2352x1568px · retinal fundus photograph · 45° field of view
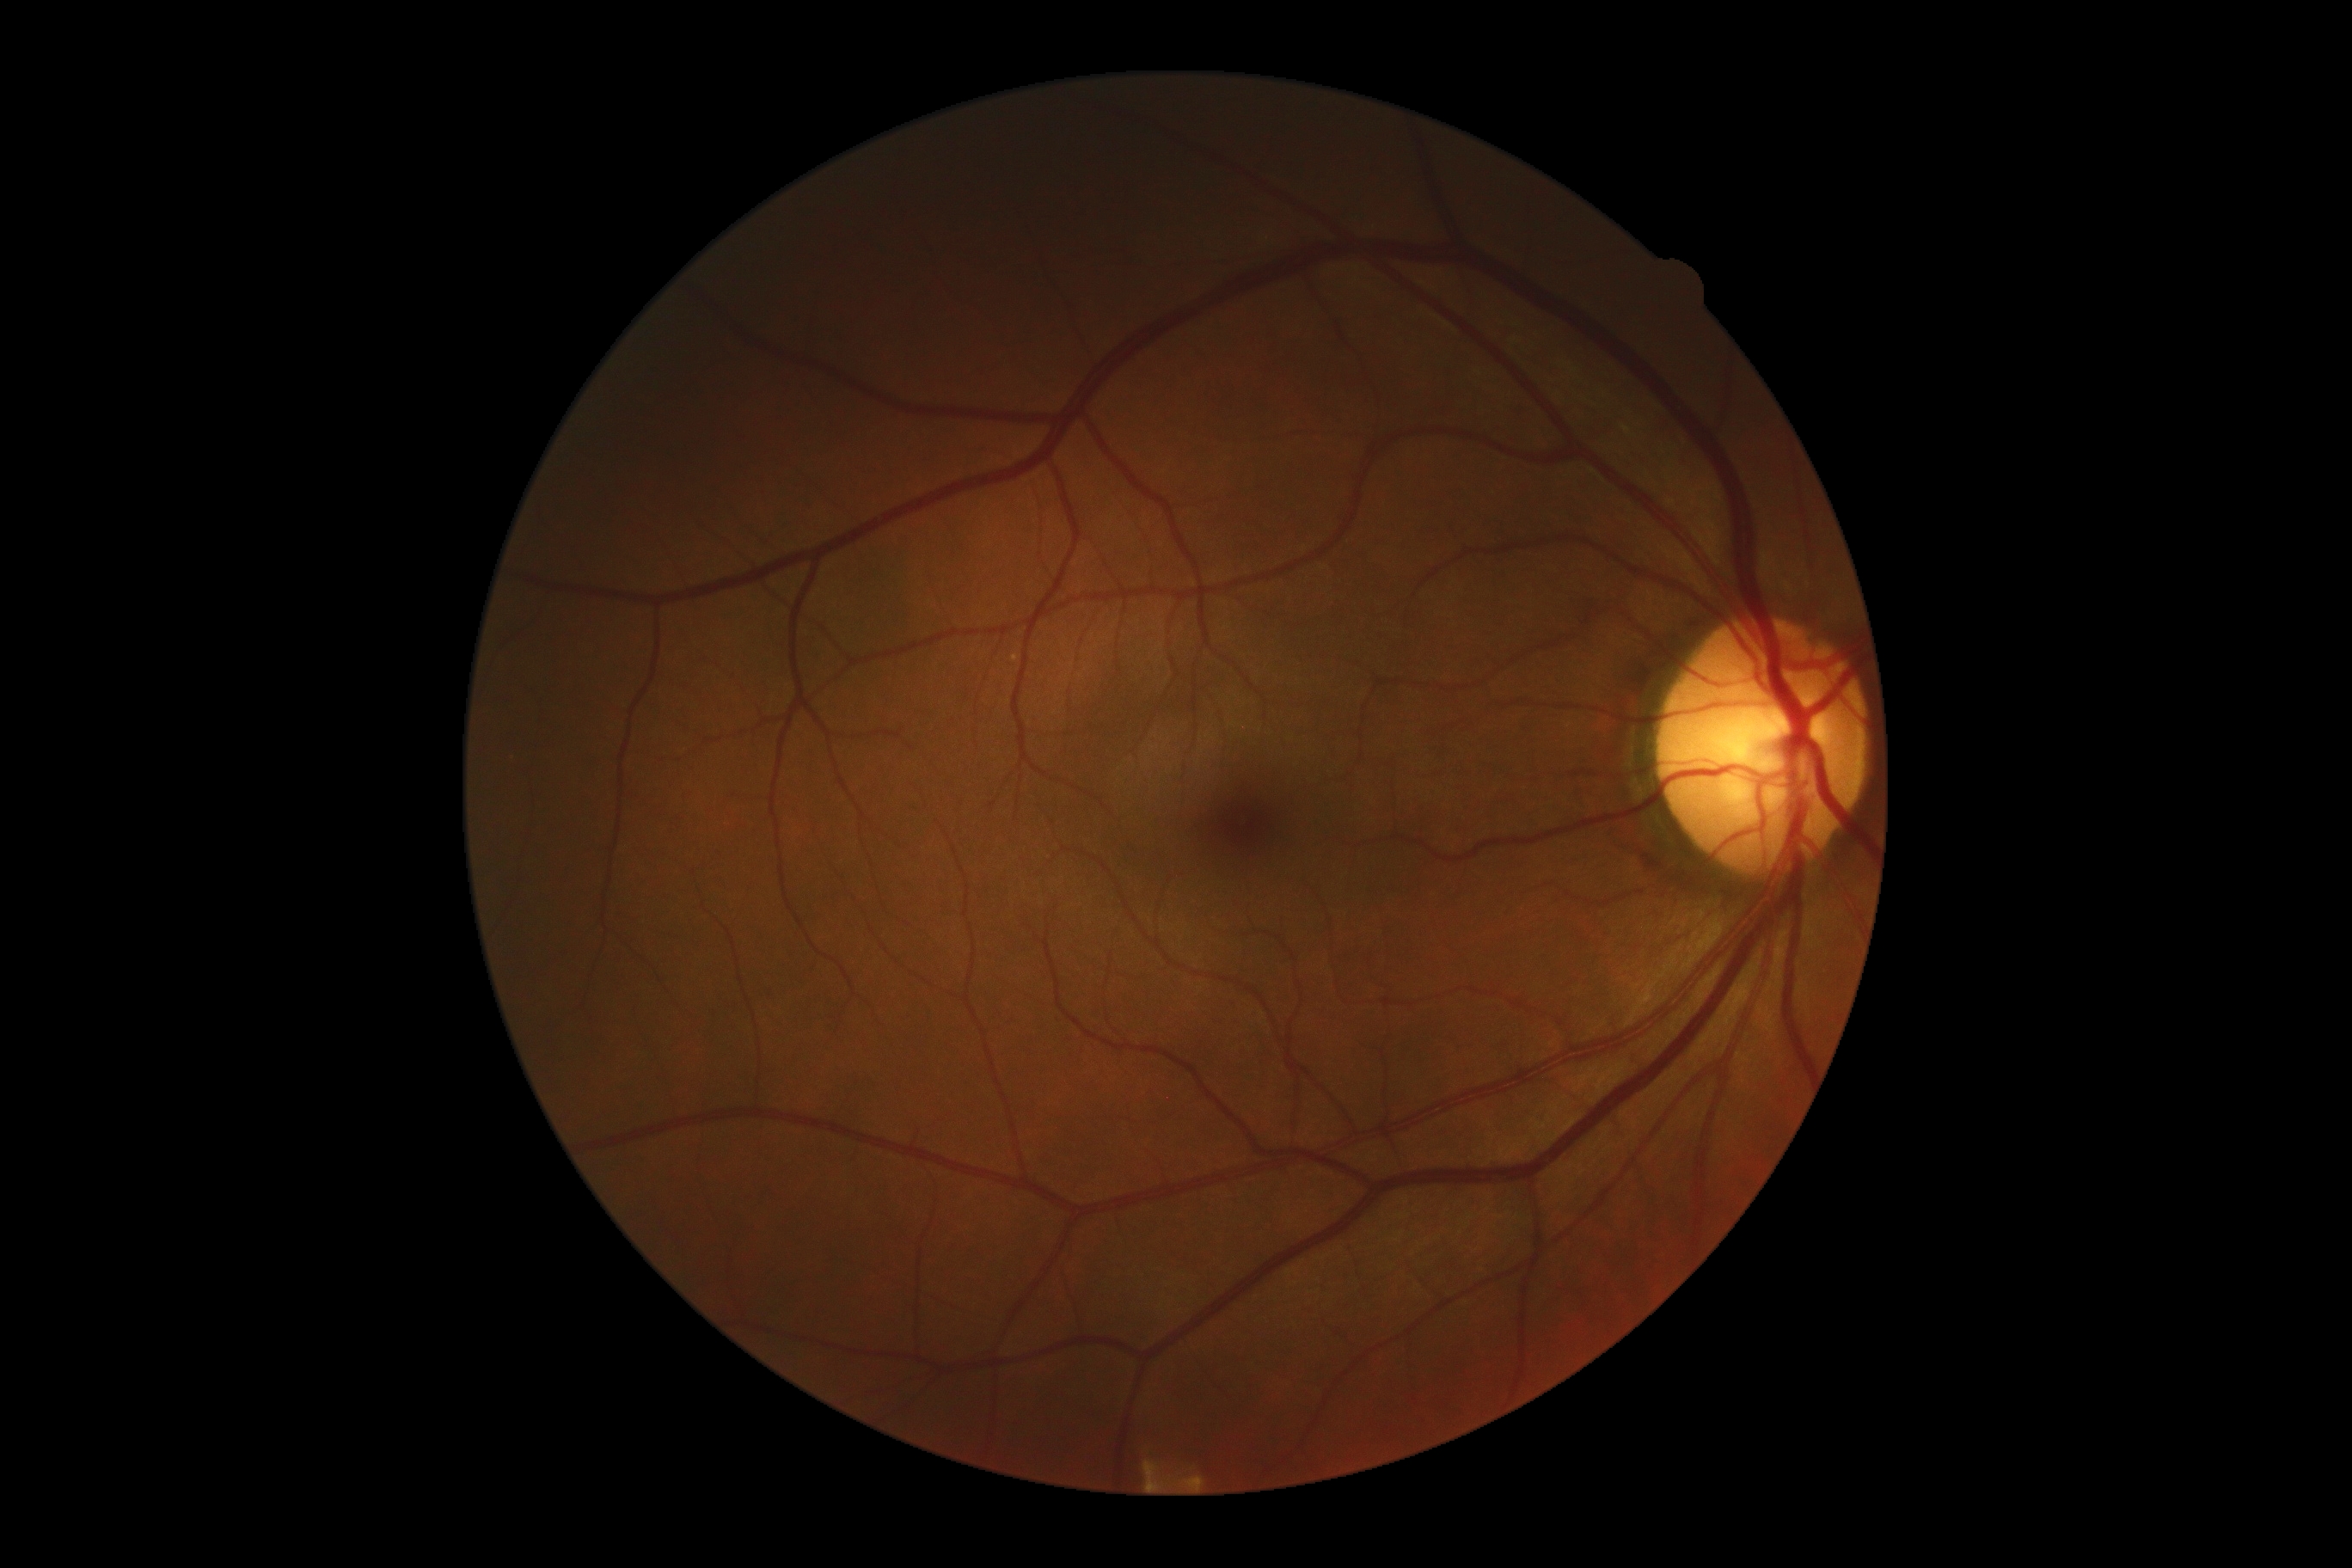
No DR findings. DR grade is no apparent retinopathy (0) — no visible signs of diabetic retinopathy.